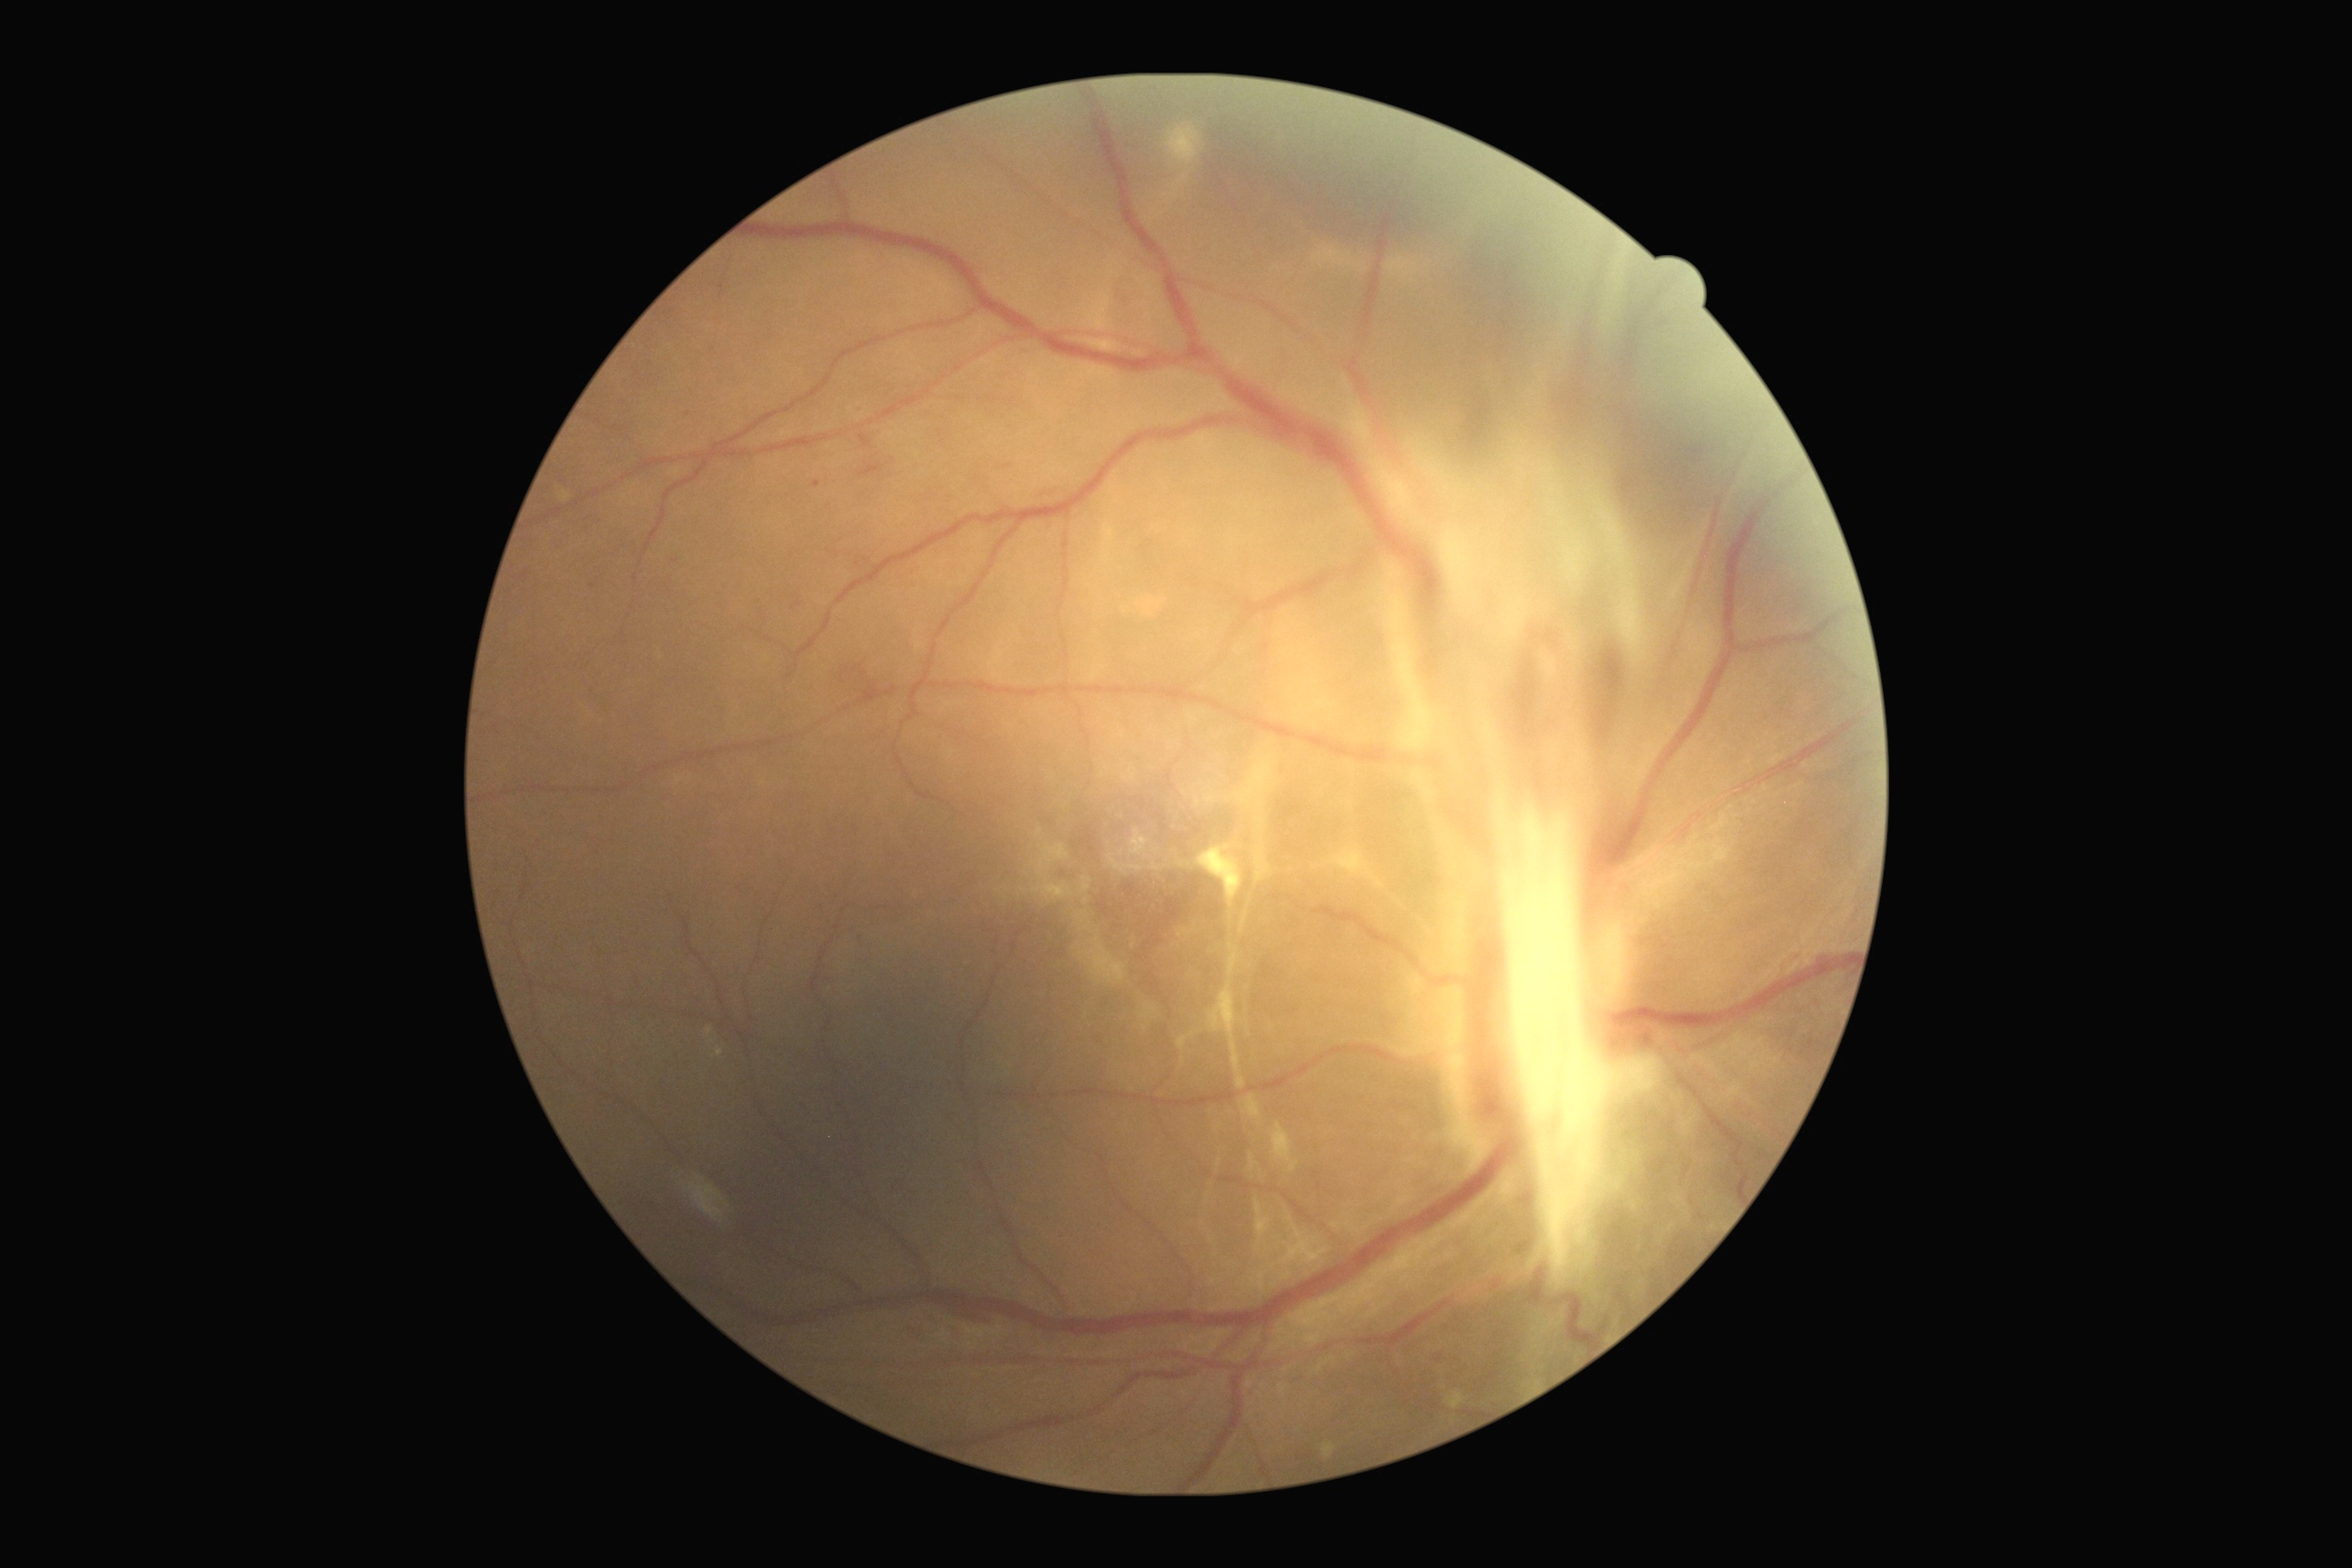
Annotations:
• DR grade — 4 (PDR) — neovascularization and/or vitreous/pre-retinal hemorrhage